RetCam wide-field infant fundus image: 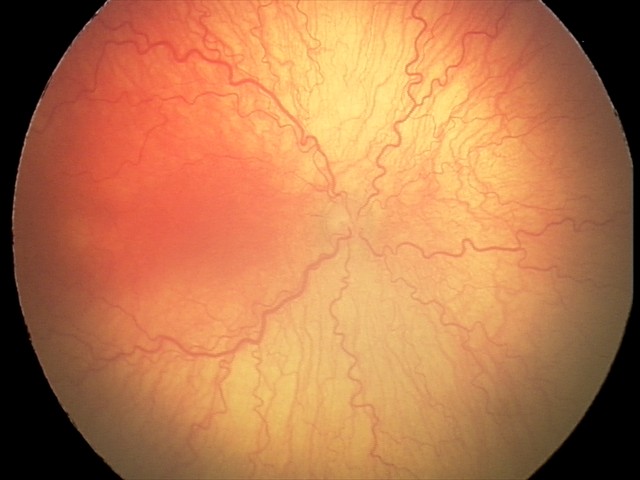
Q: What was the screening finding?
A: aggressive retinopathy of prematurity (A-ROP)
Q: Plus disease status?
A: plus disease